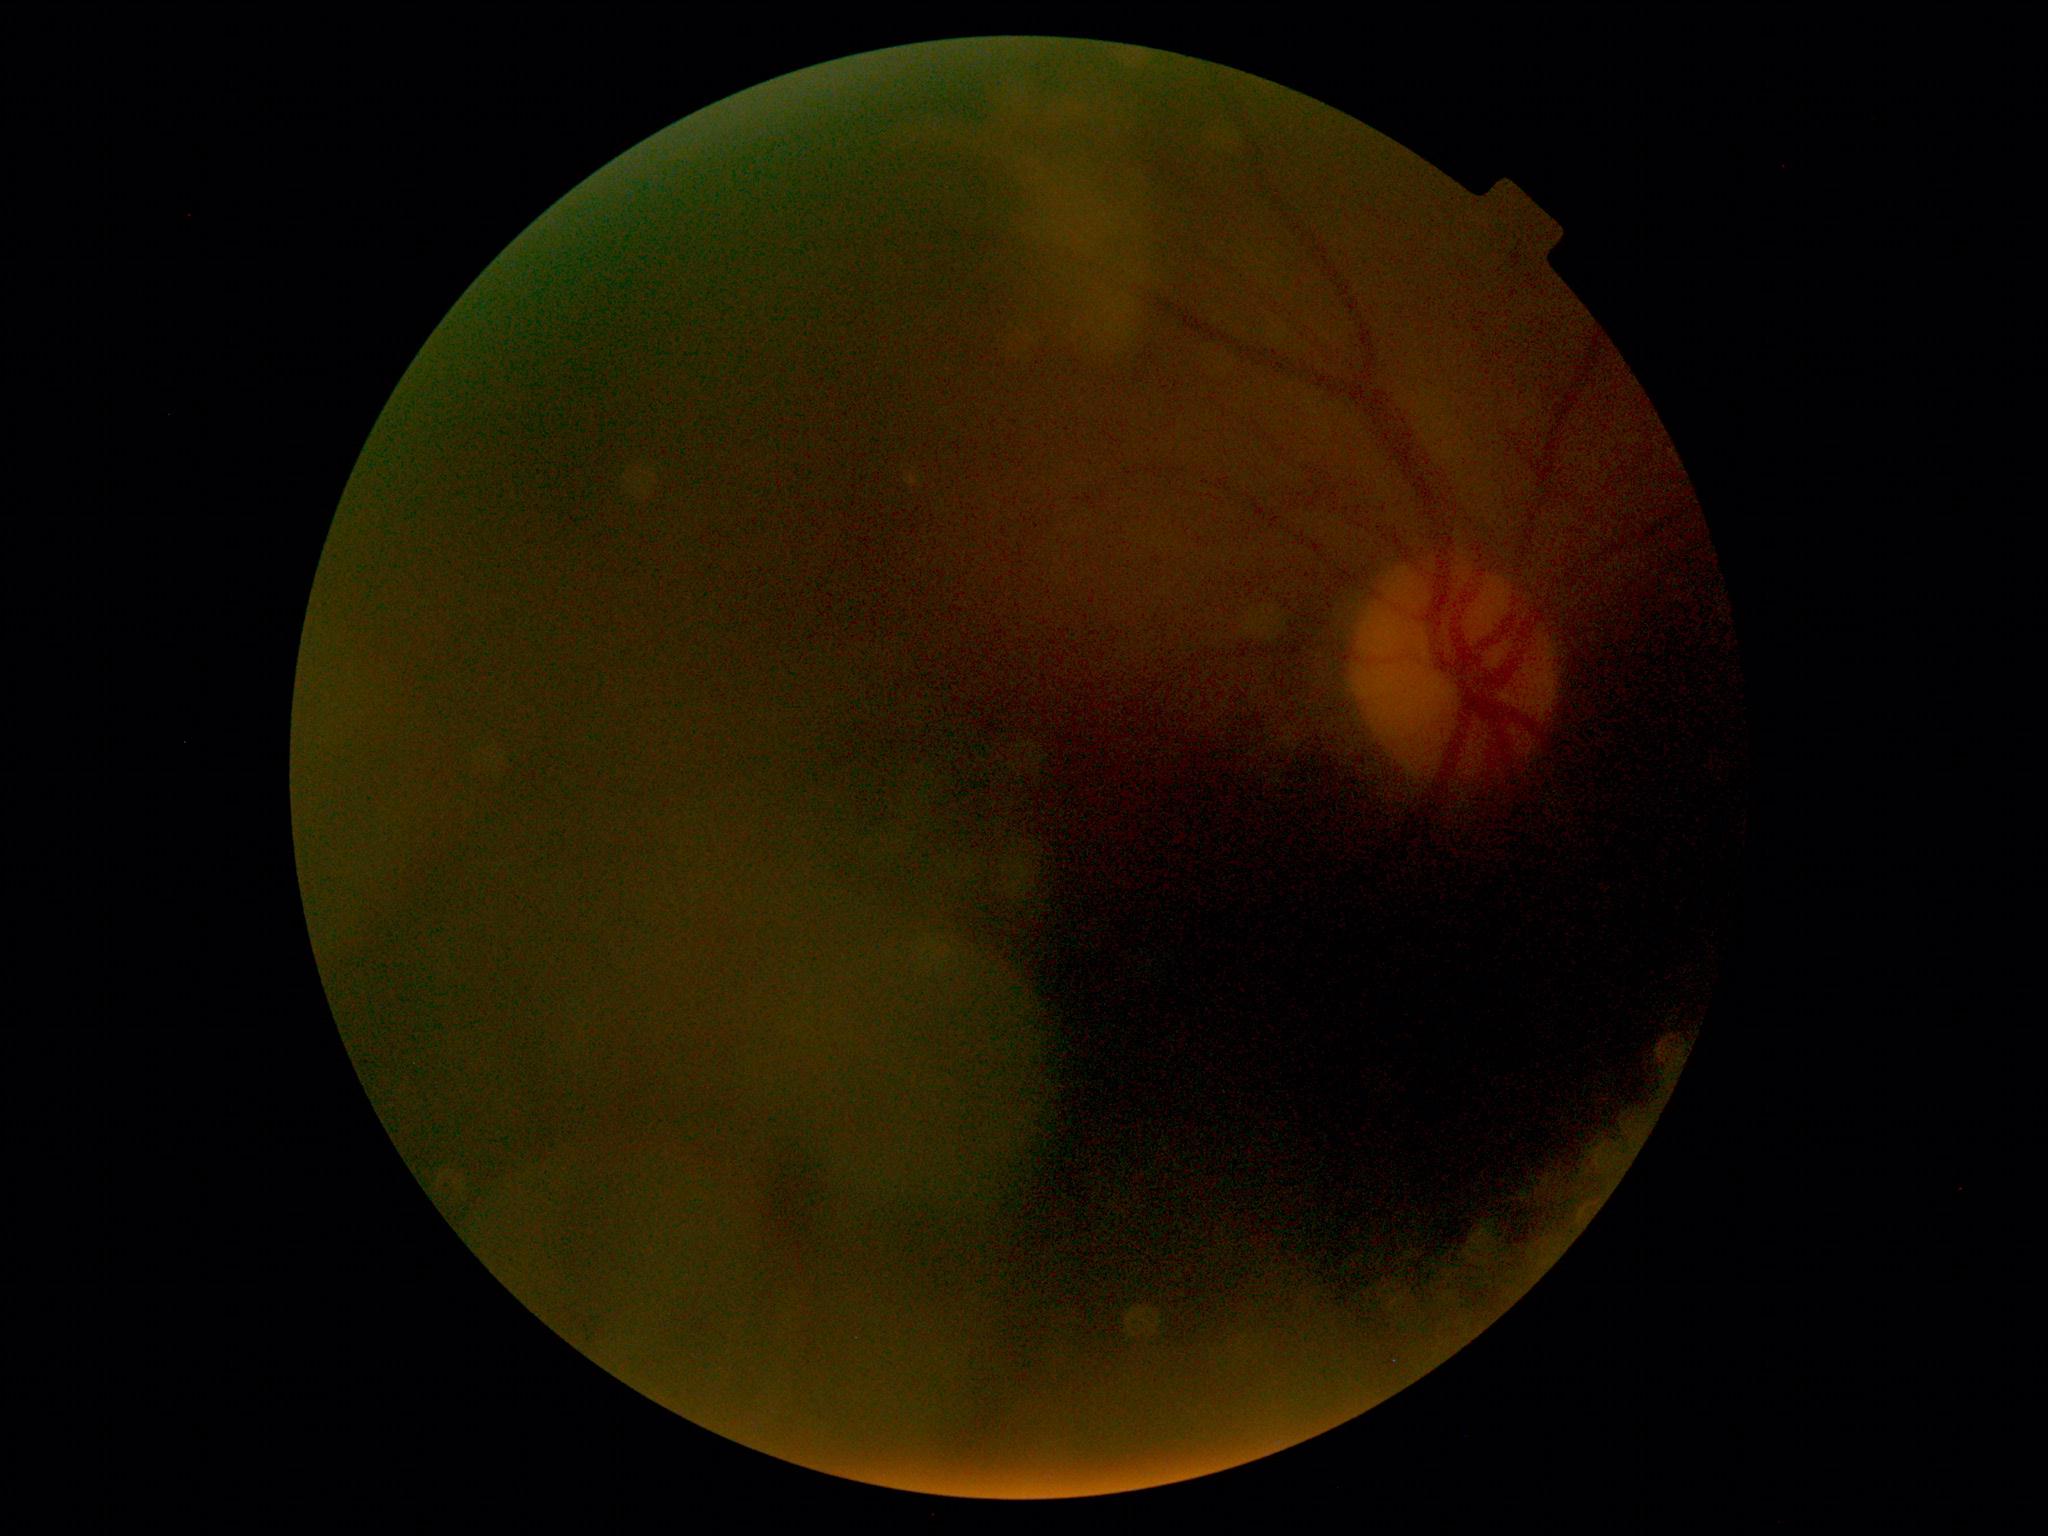
The image cannot be graded for diabetic retinopathy. Diabetic retinopathy (DR): ungradable.